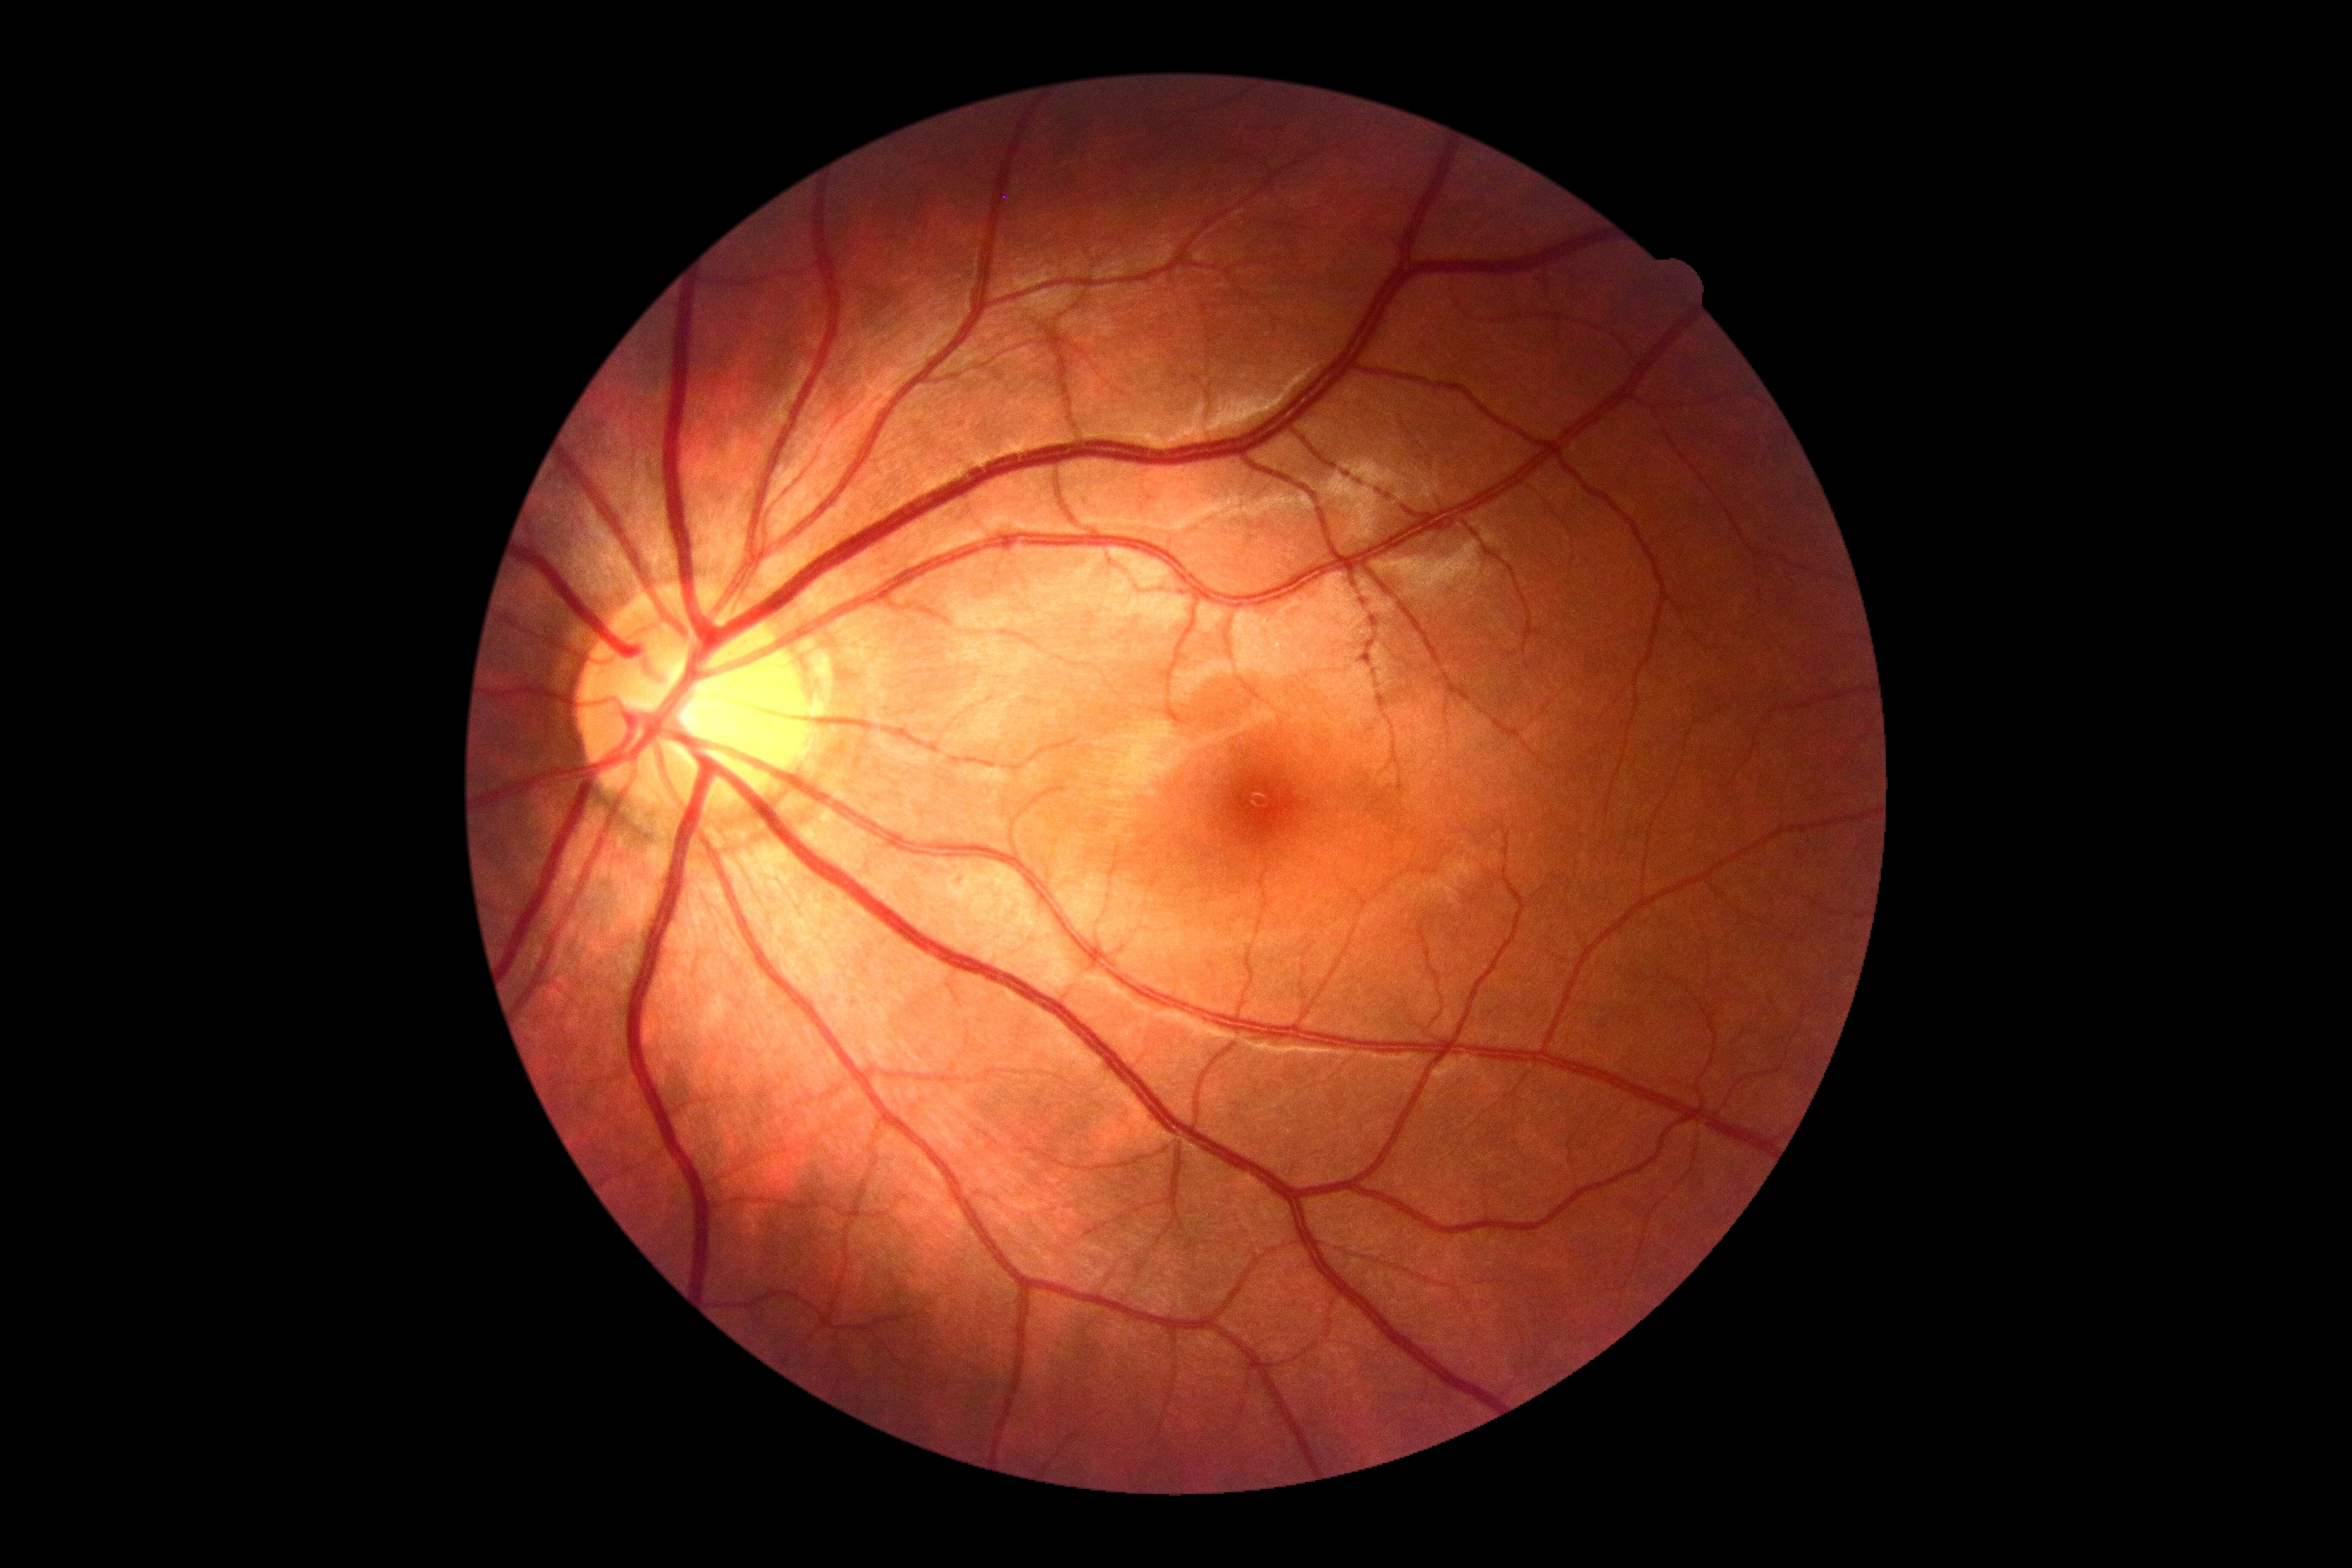

{"dr_grade": "grade 0"}